45° FOV: 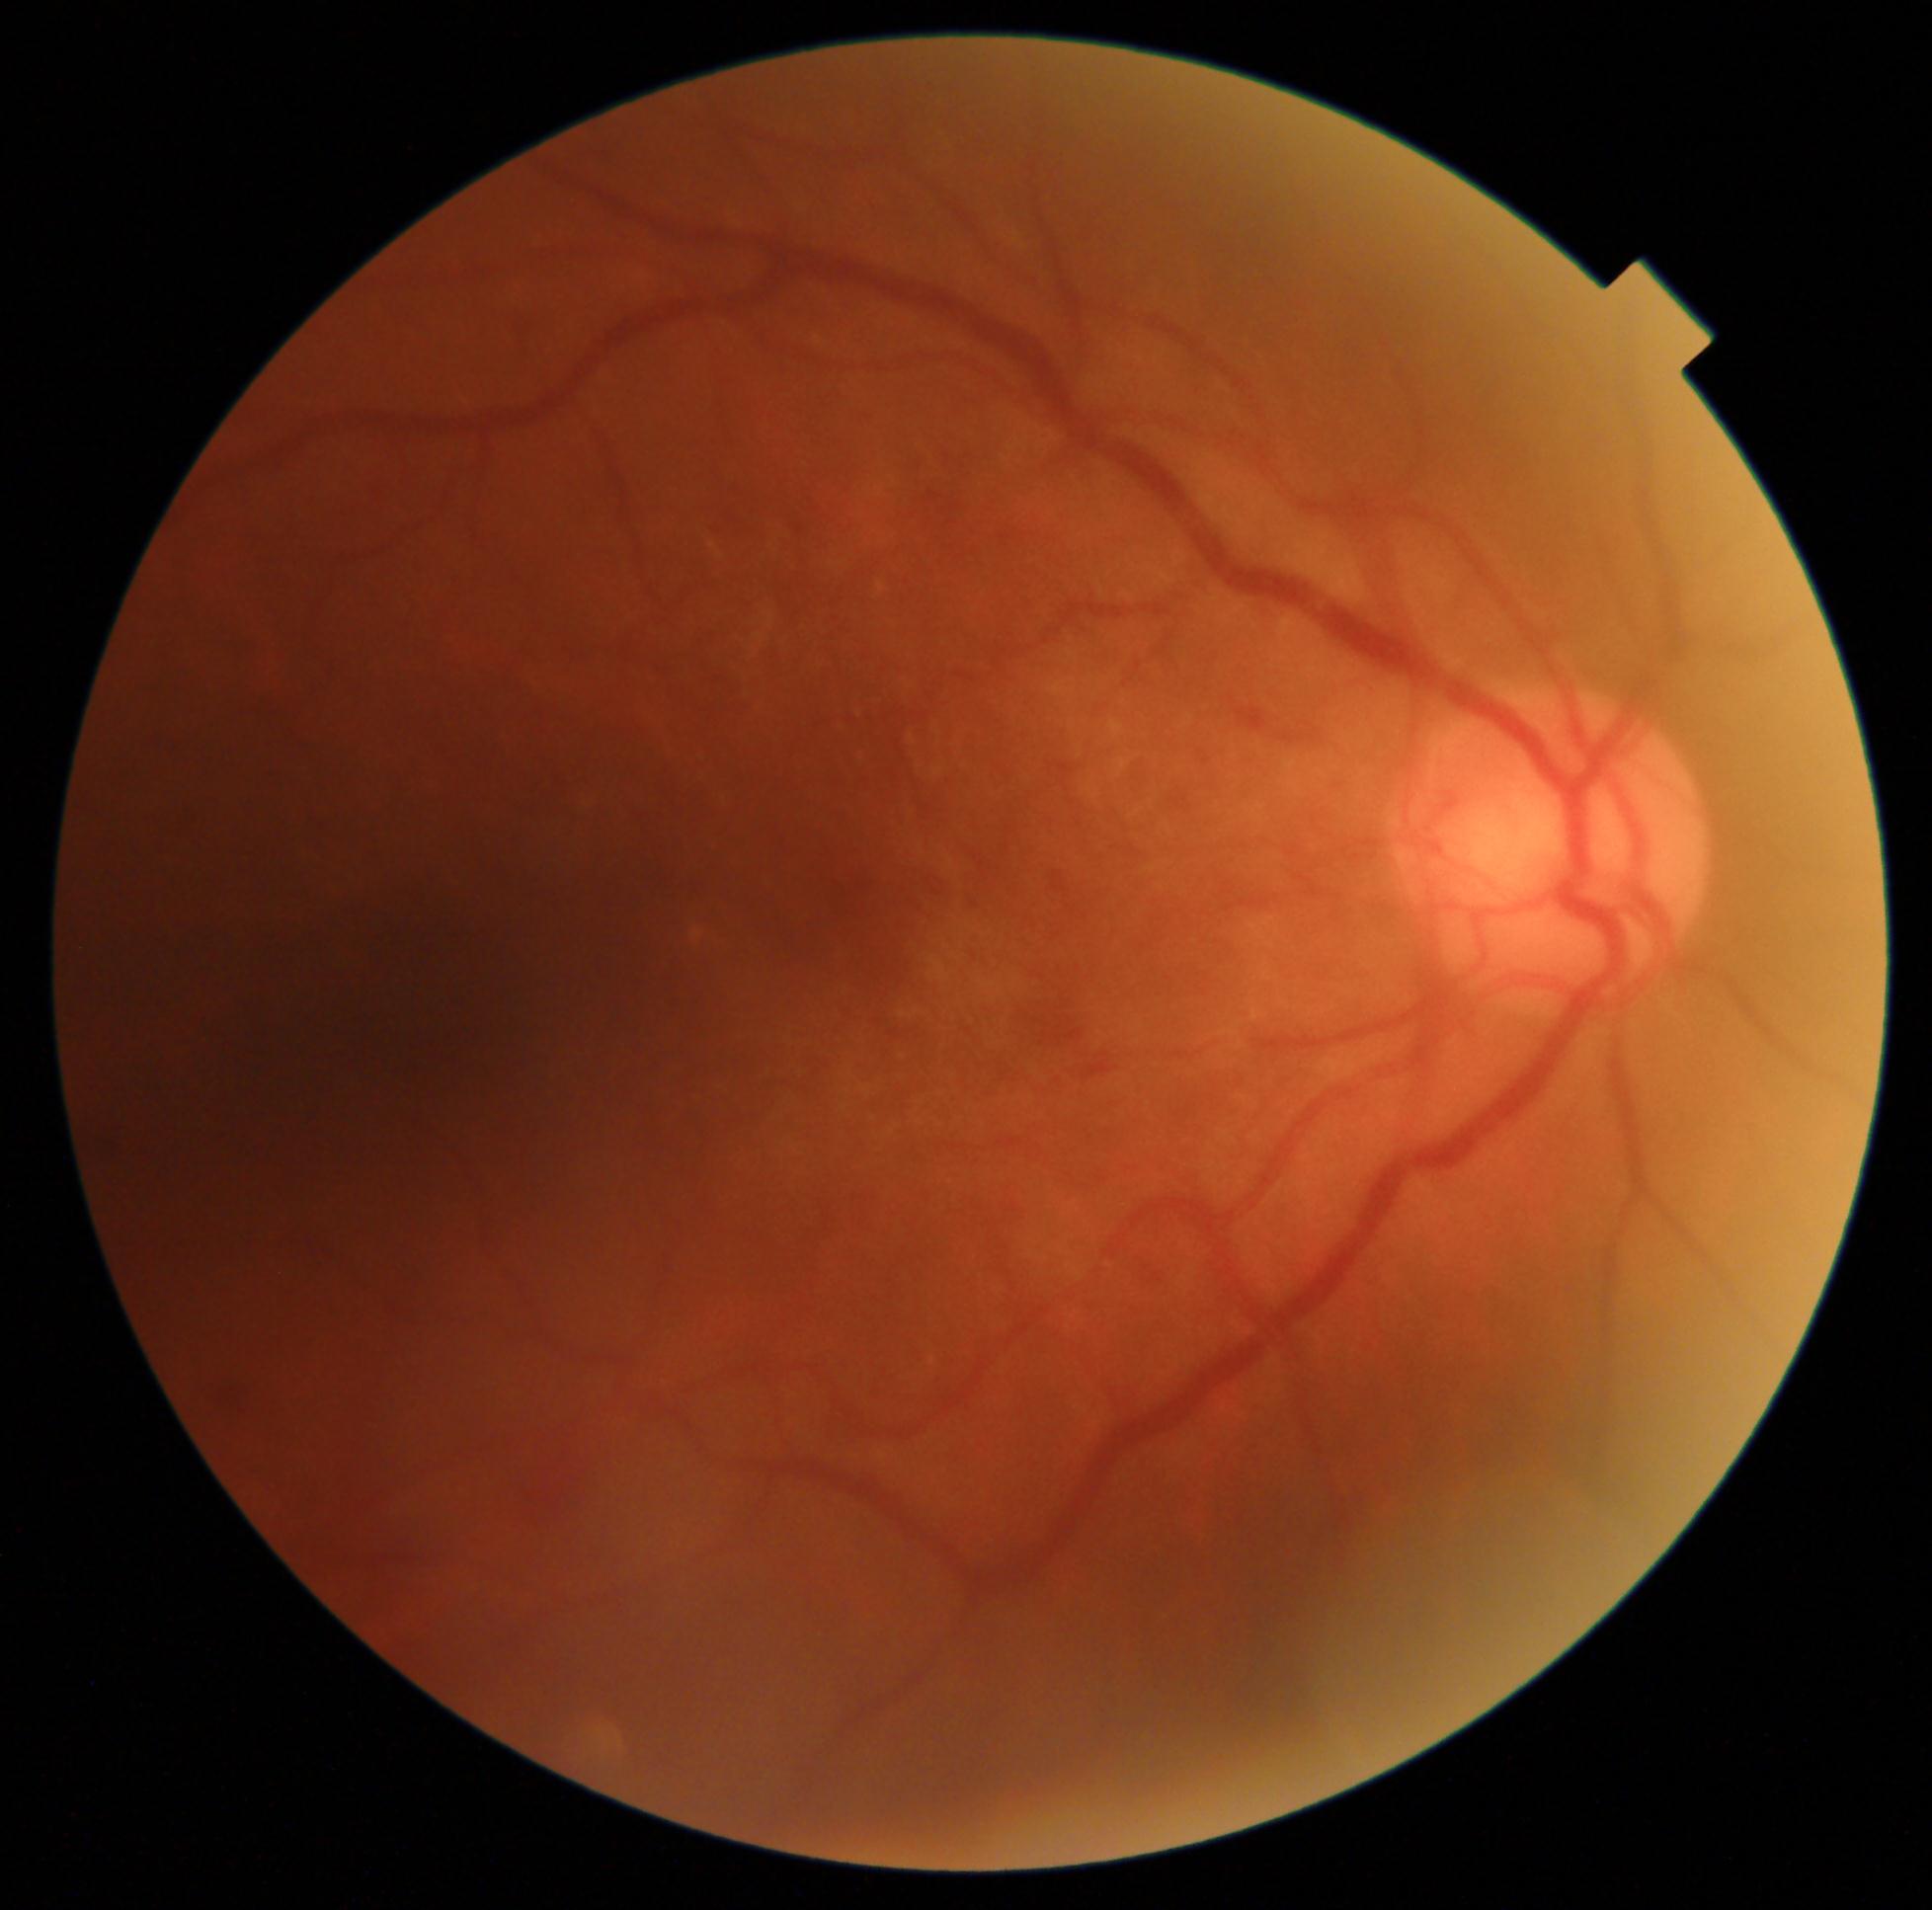 Disease class: non-proliferative diabetic retinopathy. DR severity is grade 2.